2048 by 1536 pixels · fundus photo: 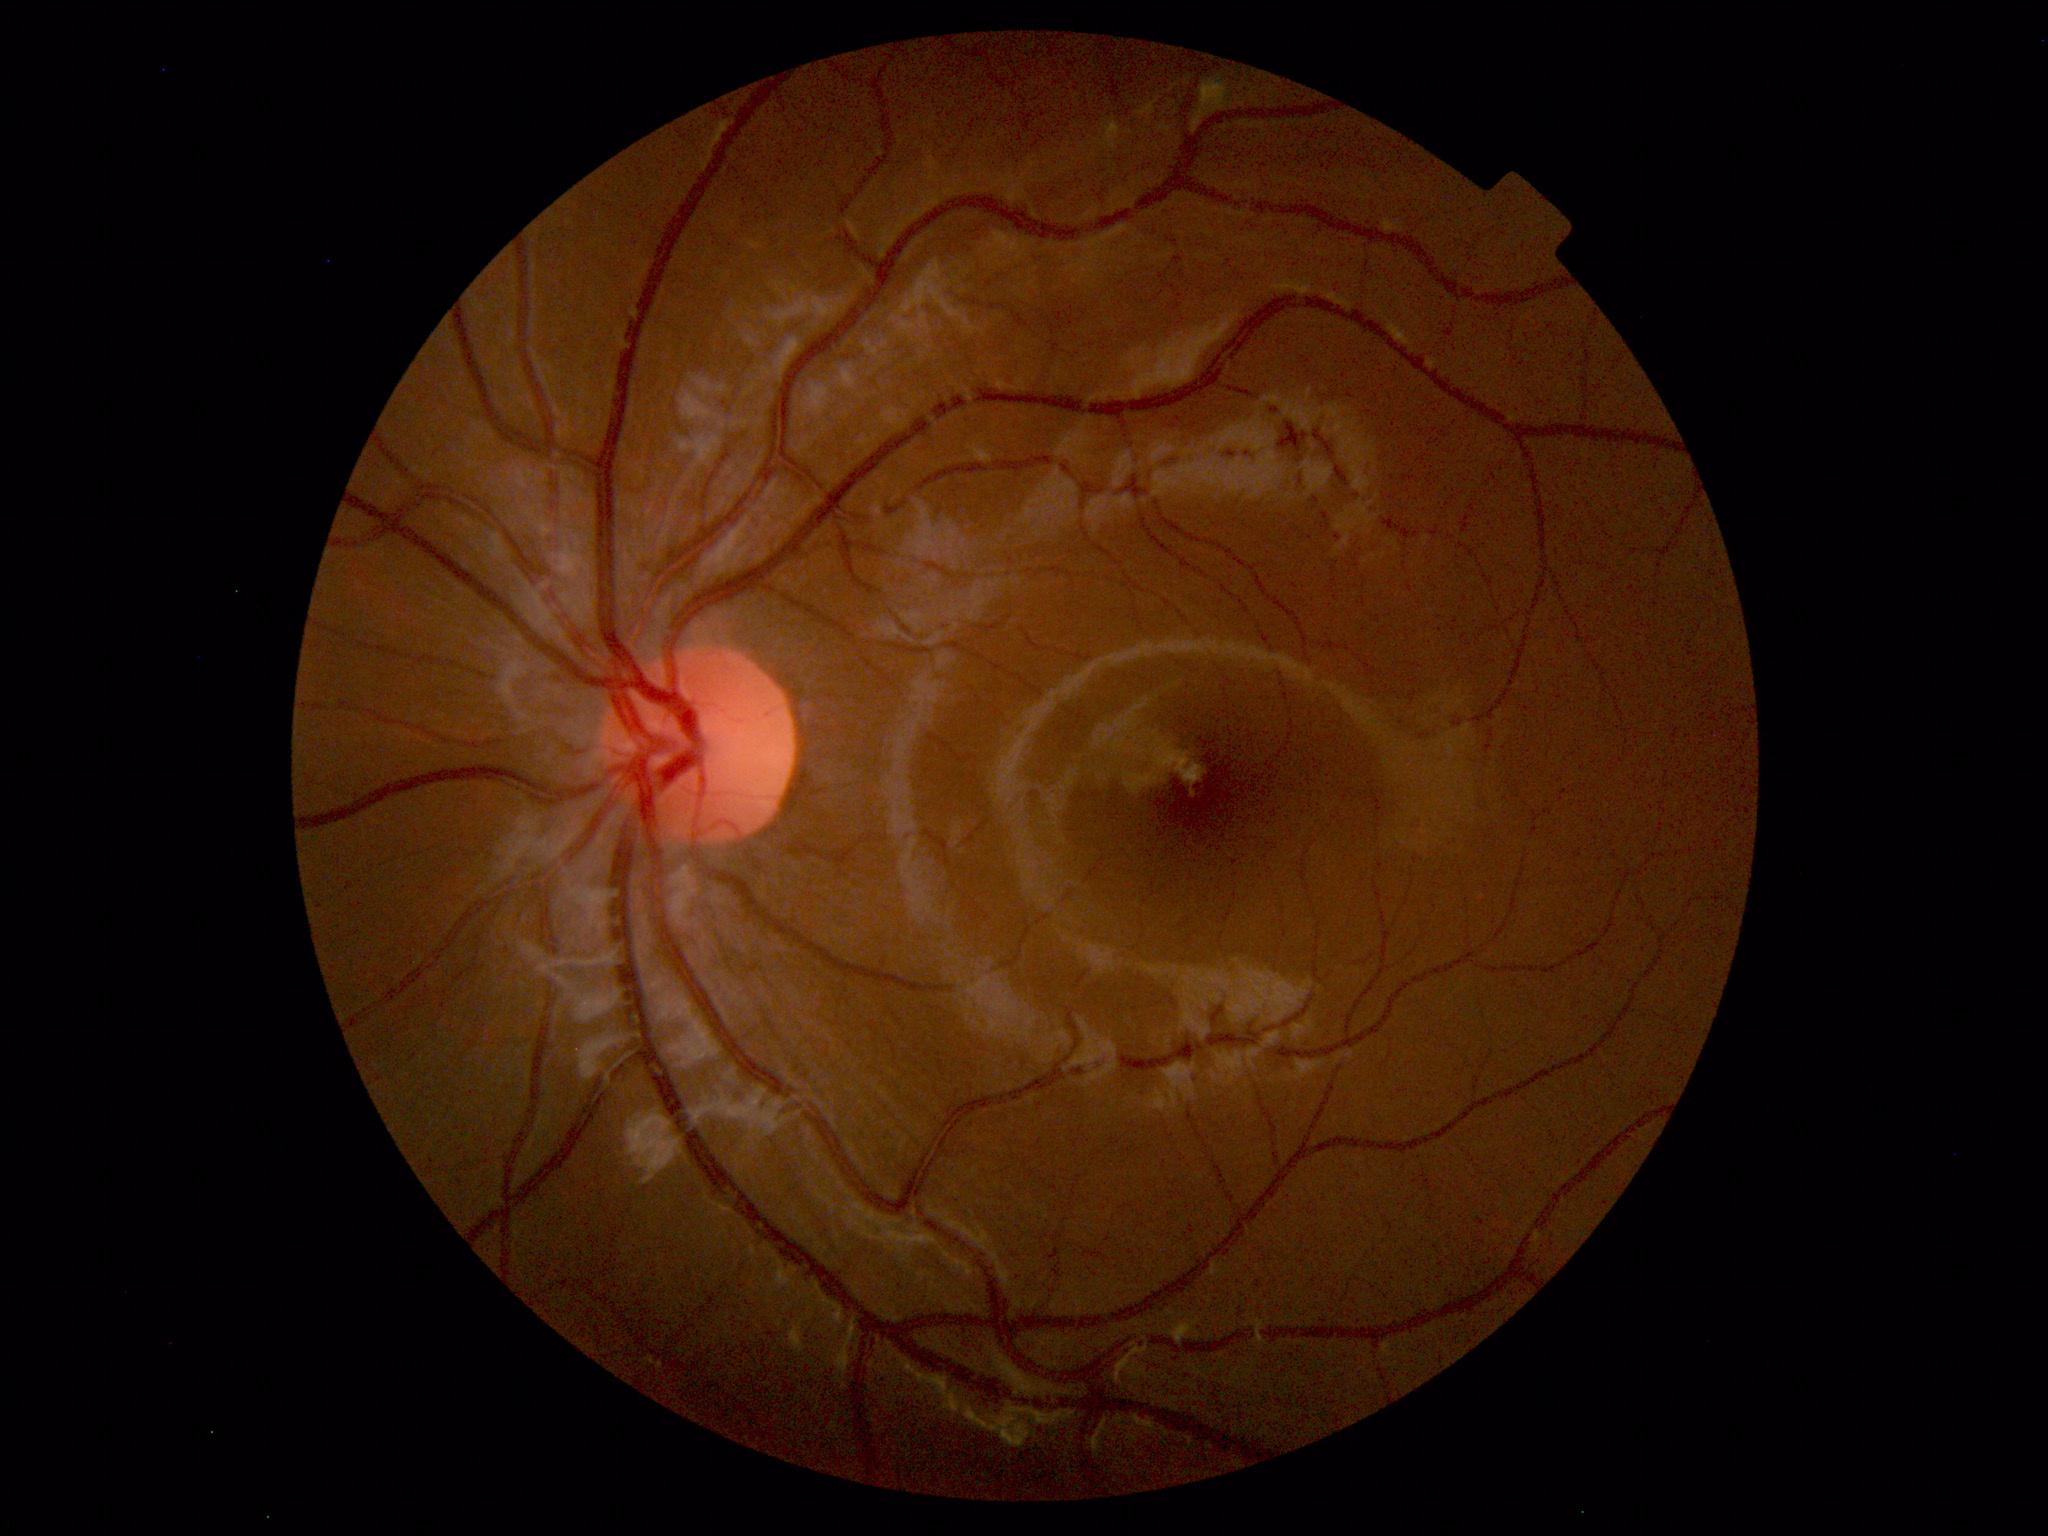
Diagnosis: normal.